Color fundus image: 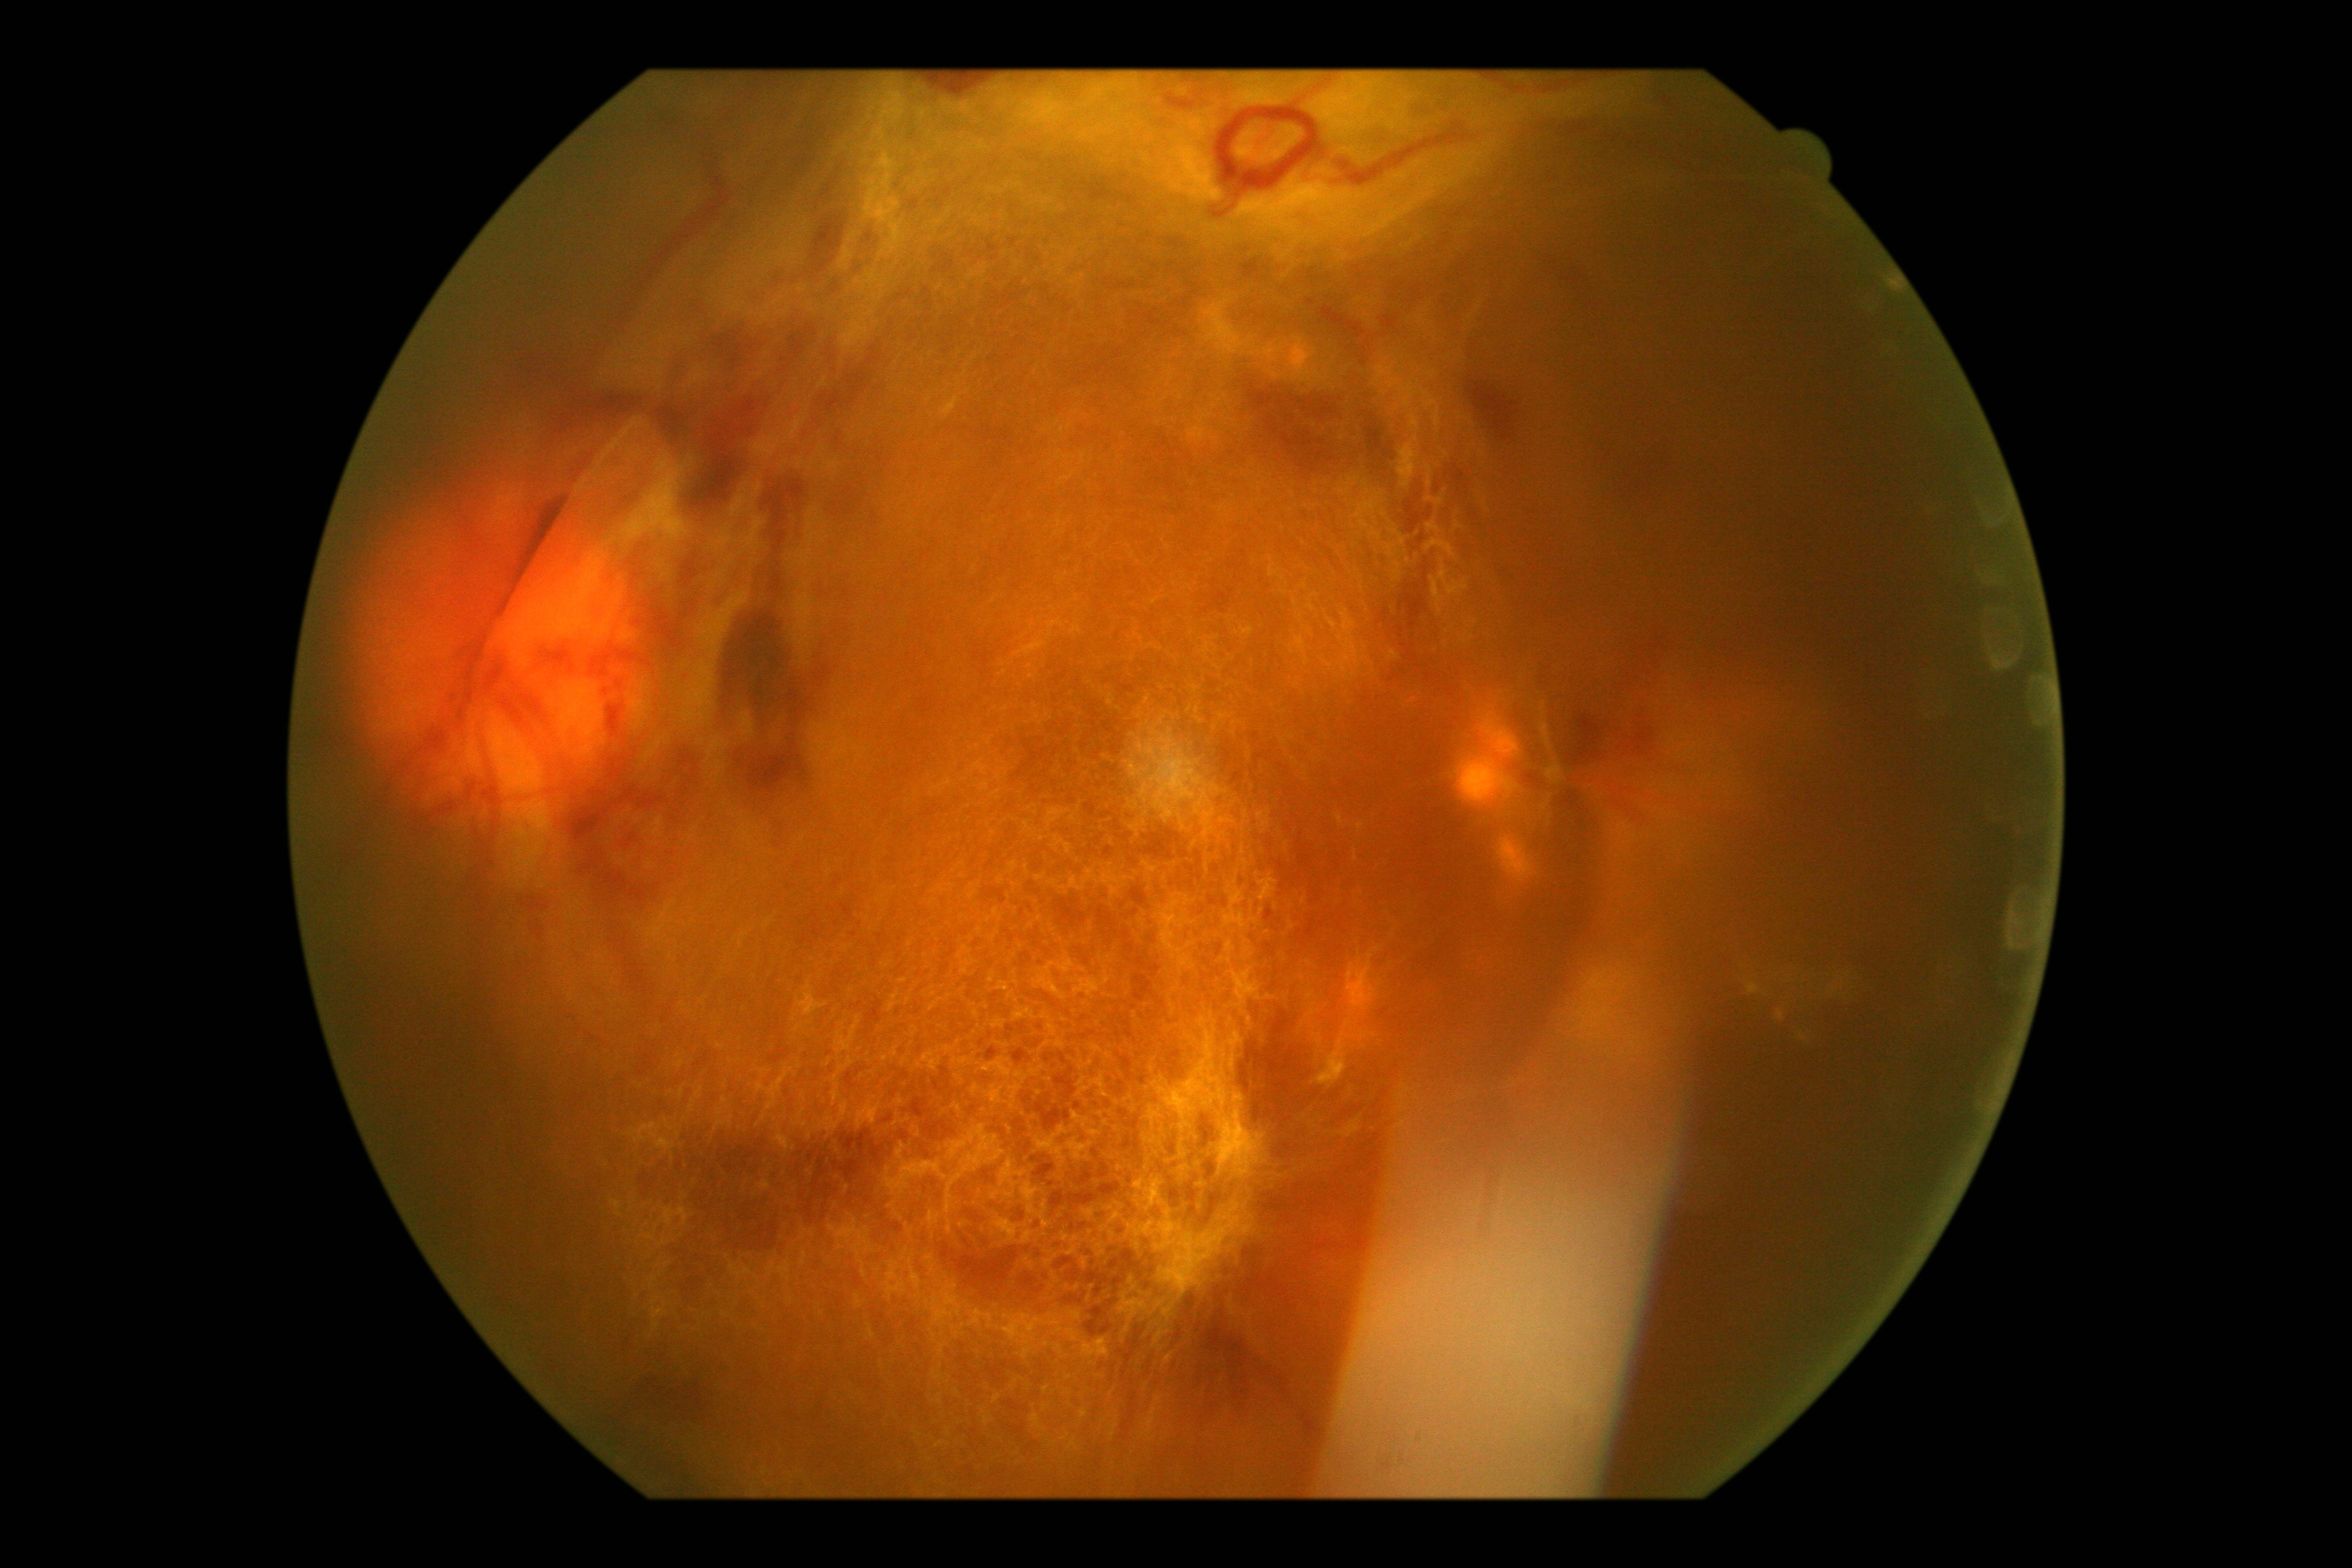   dr_grade: grade 4 (PDR) — neovascularization and/or vitreous/pre-retinal hemorrhage